640x480. Pediatric wide-field fundus photograph. Clarity RetCam 3, 130° FOV: 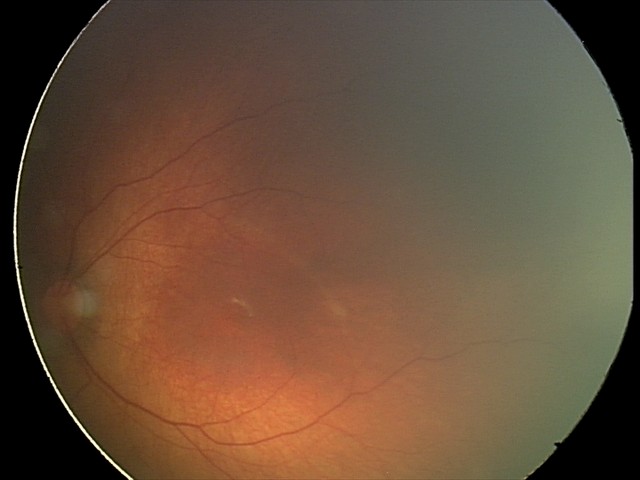 Impression = physiological.